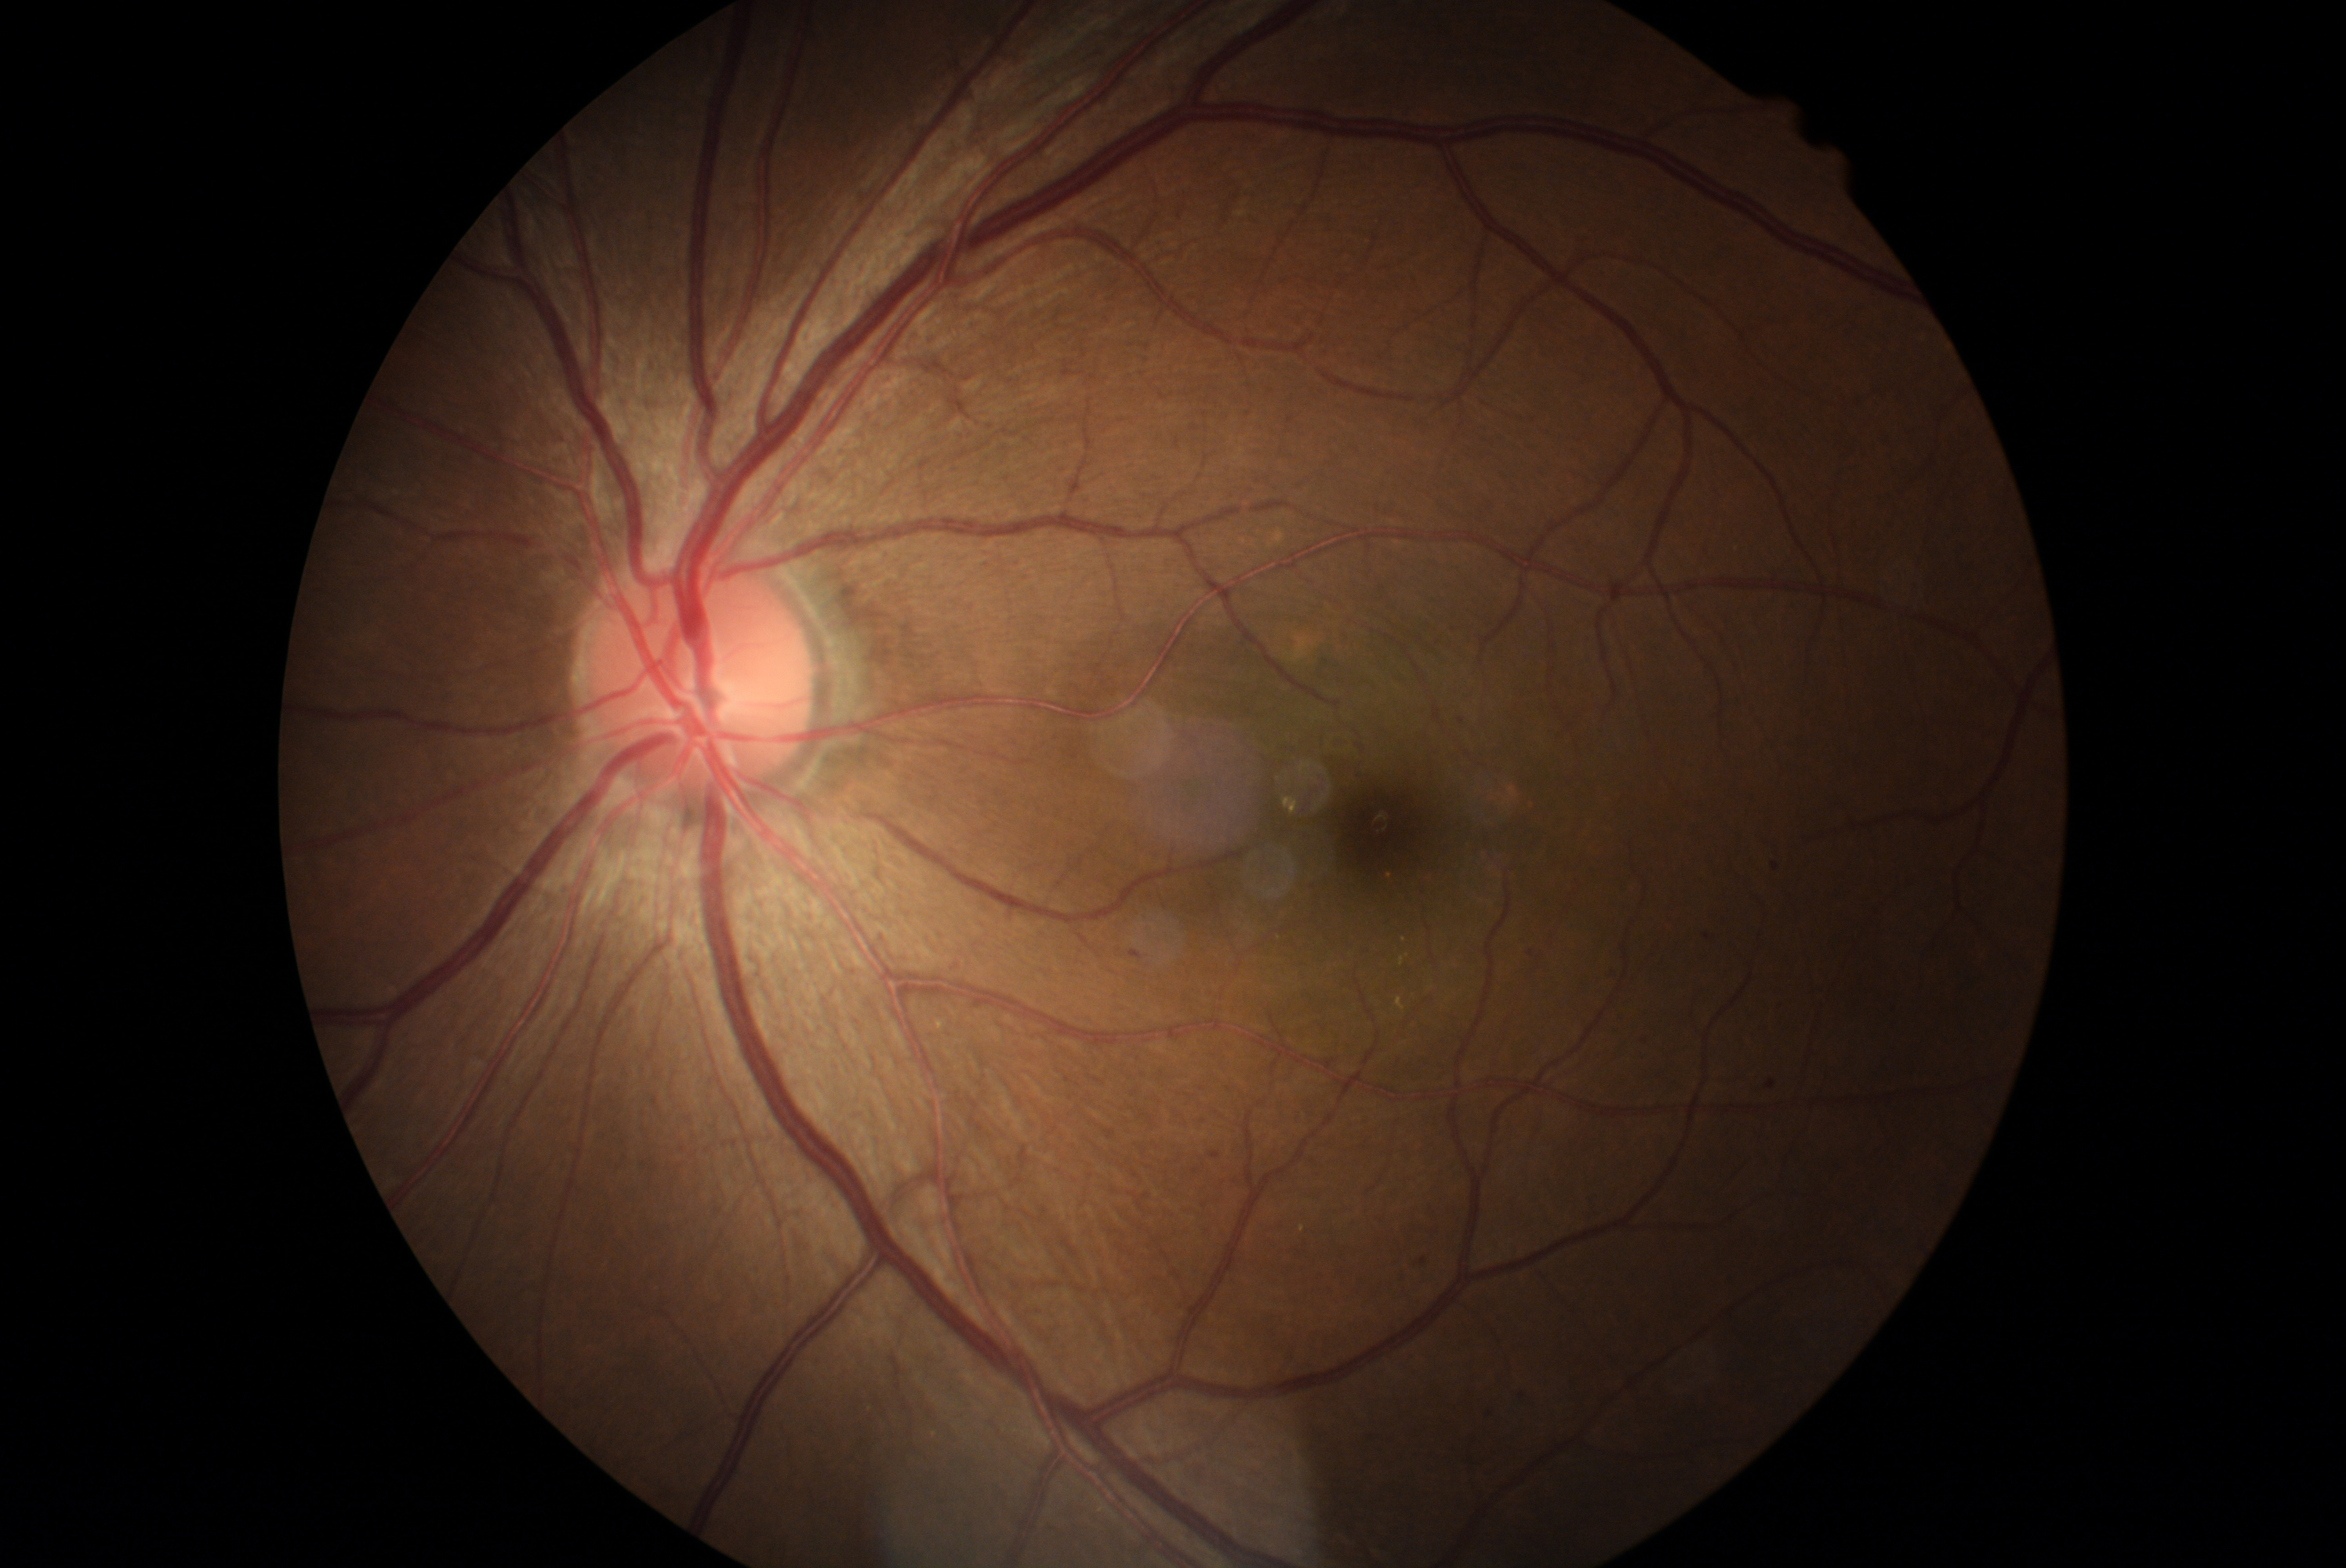 Diabetic retinopathy grade: 2/4.